1240 by 1240 pixels. Infant wide-field retinal image:
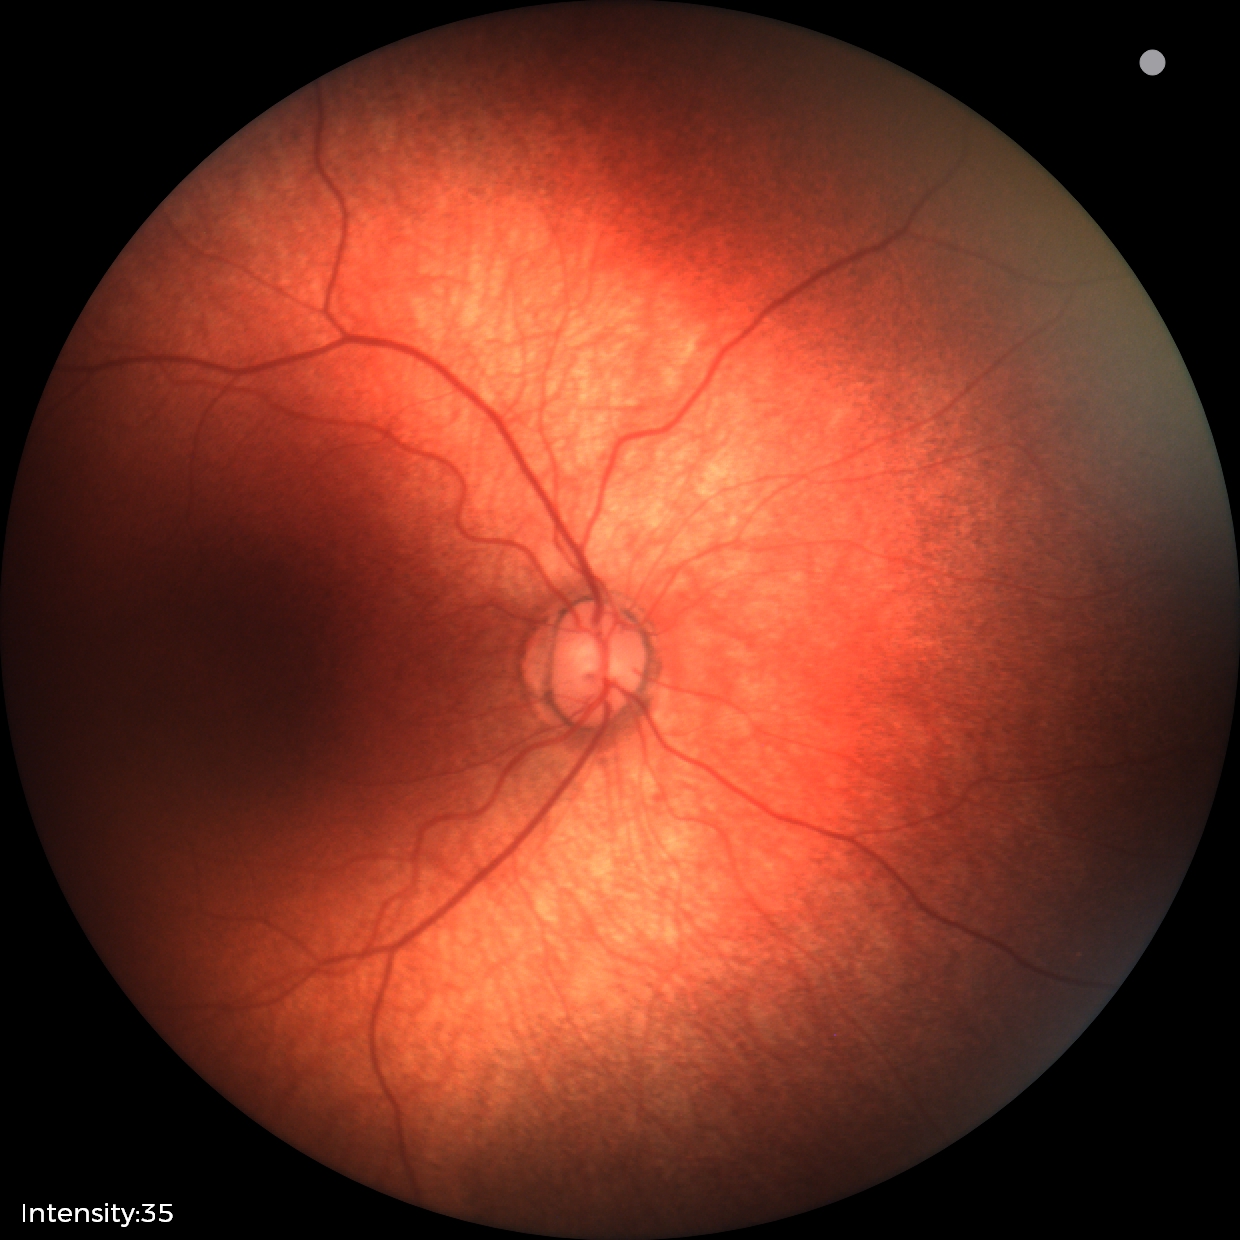 Q: What is the screening diagnosis?
A: normal fundus examination